FOV: 45 degrees · 2212 by 1659 pixels
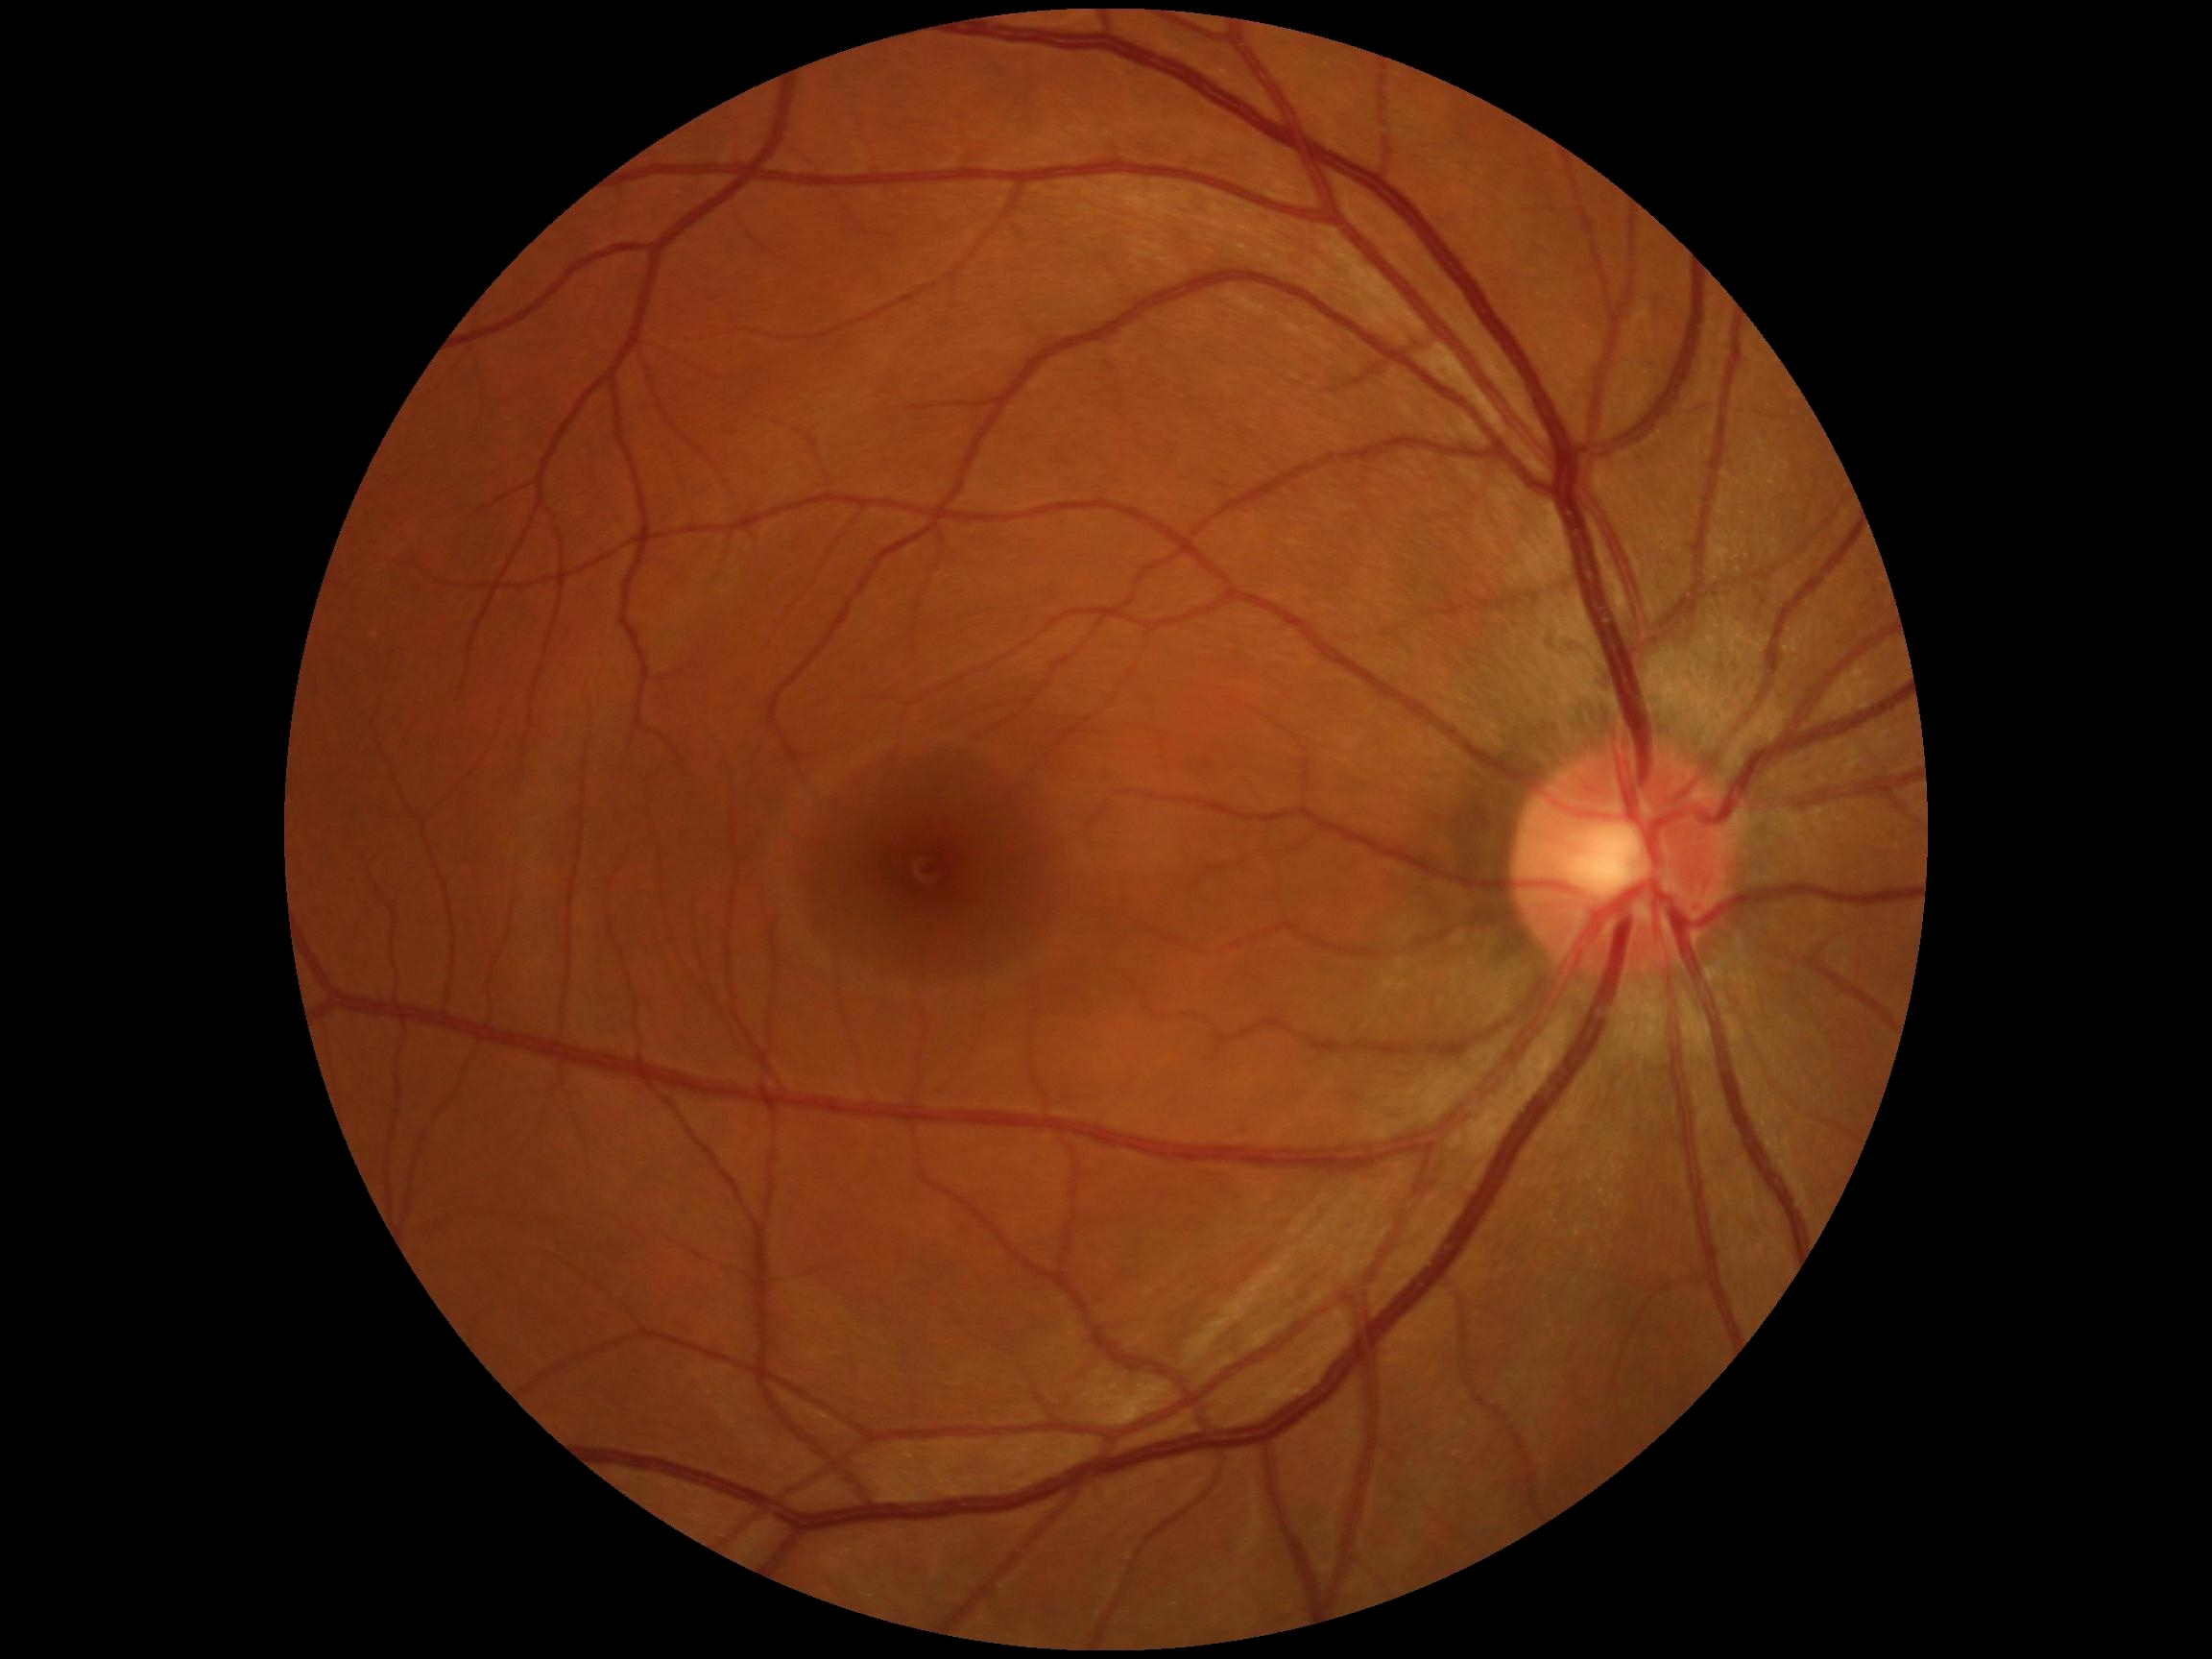

retinopathy: 0.